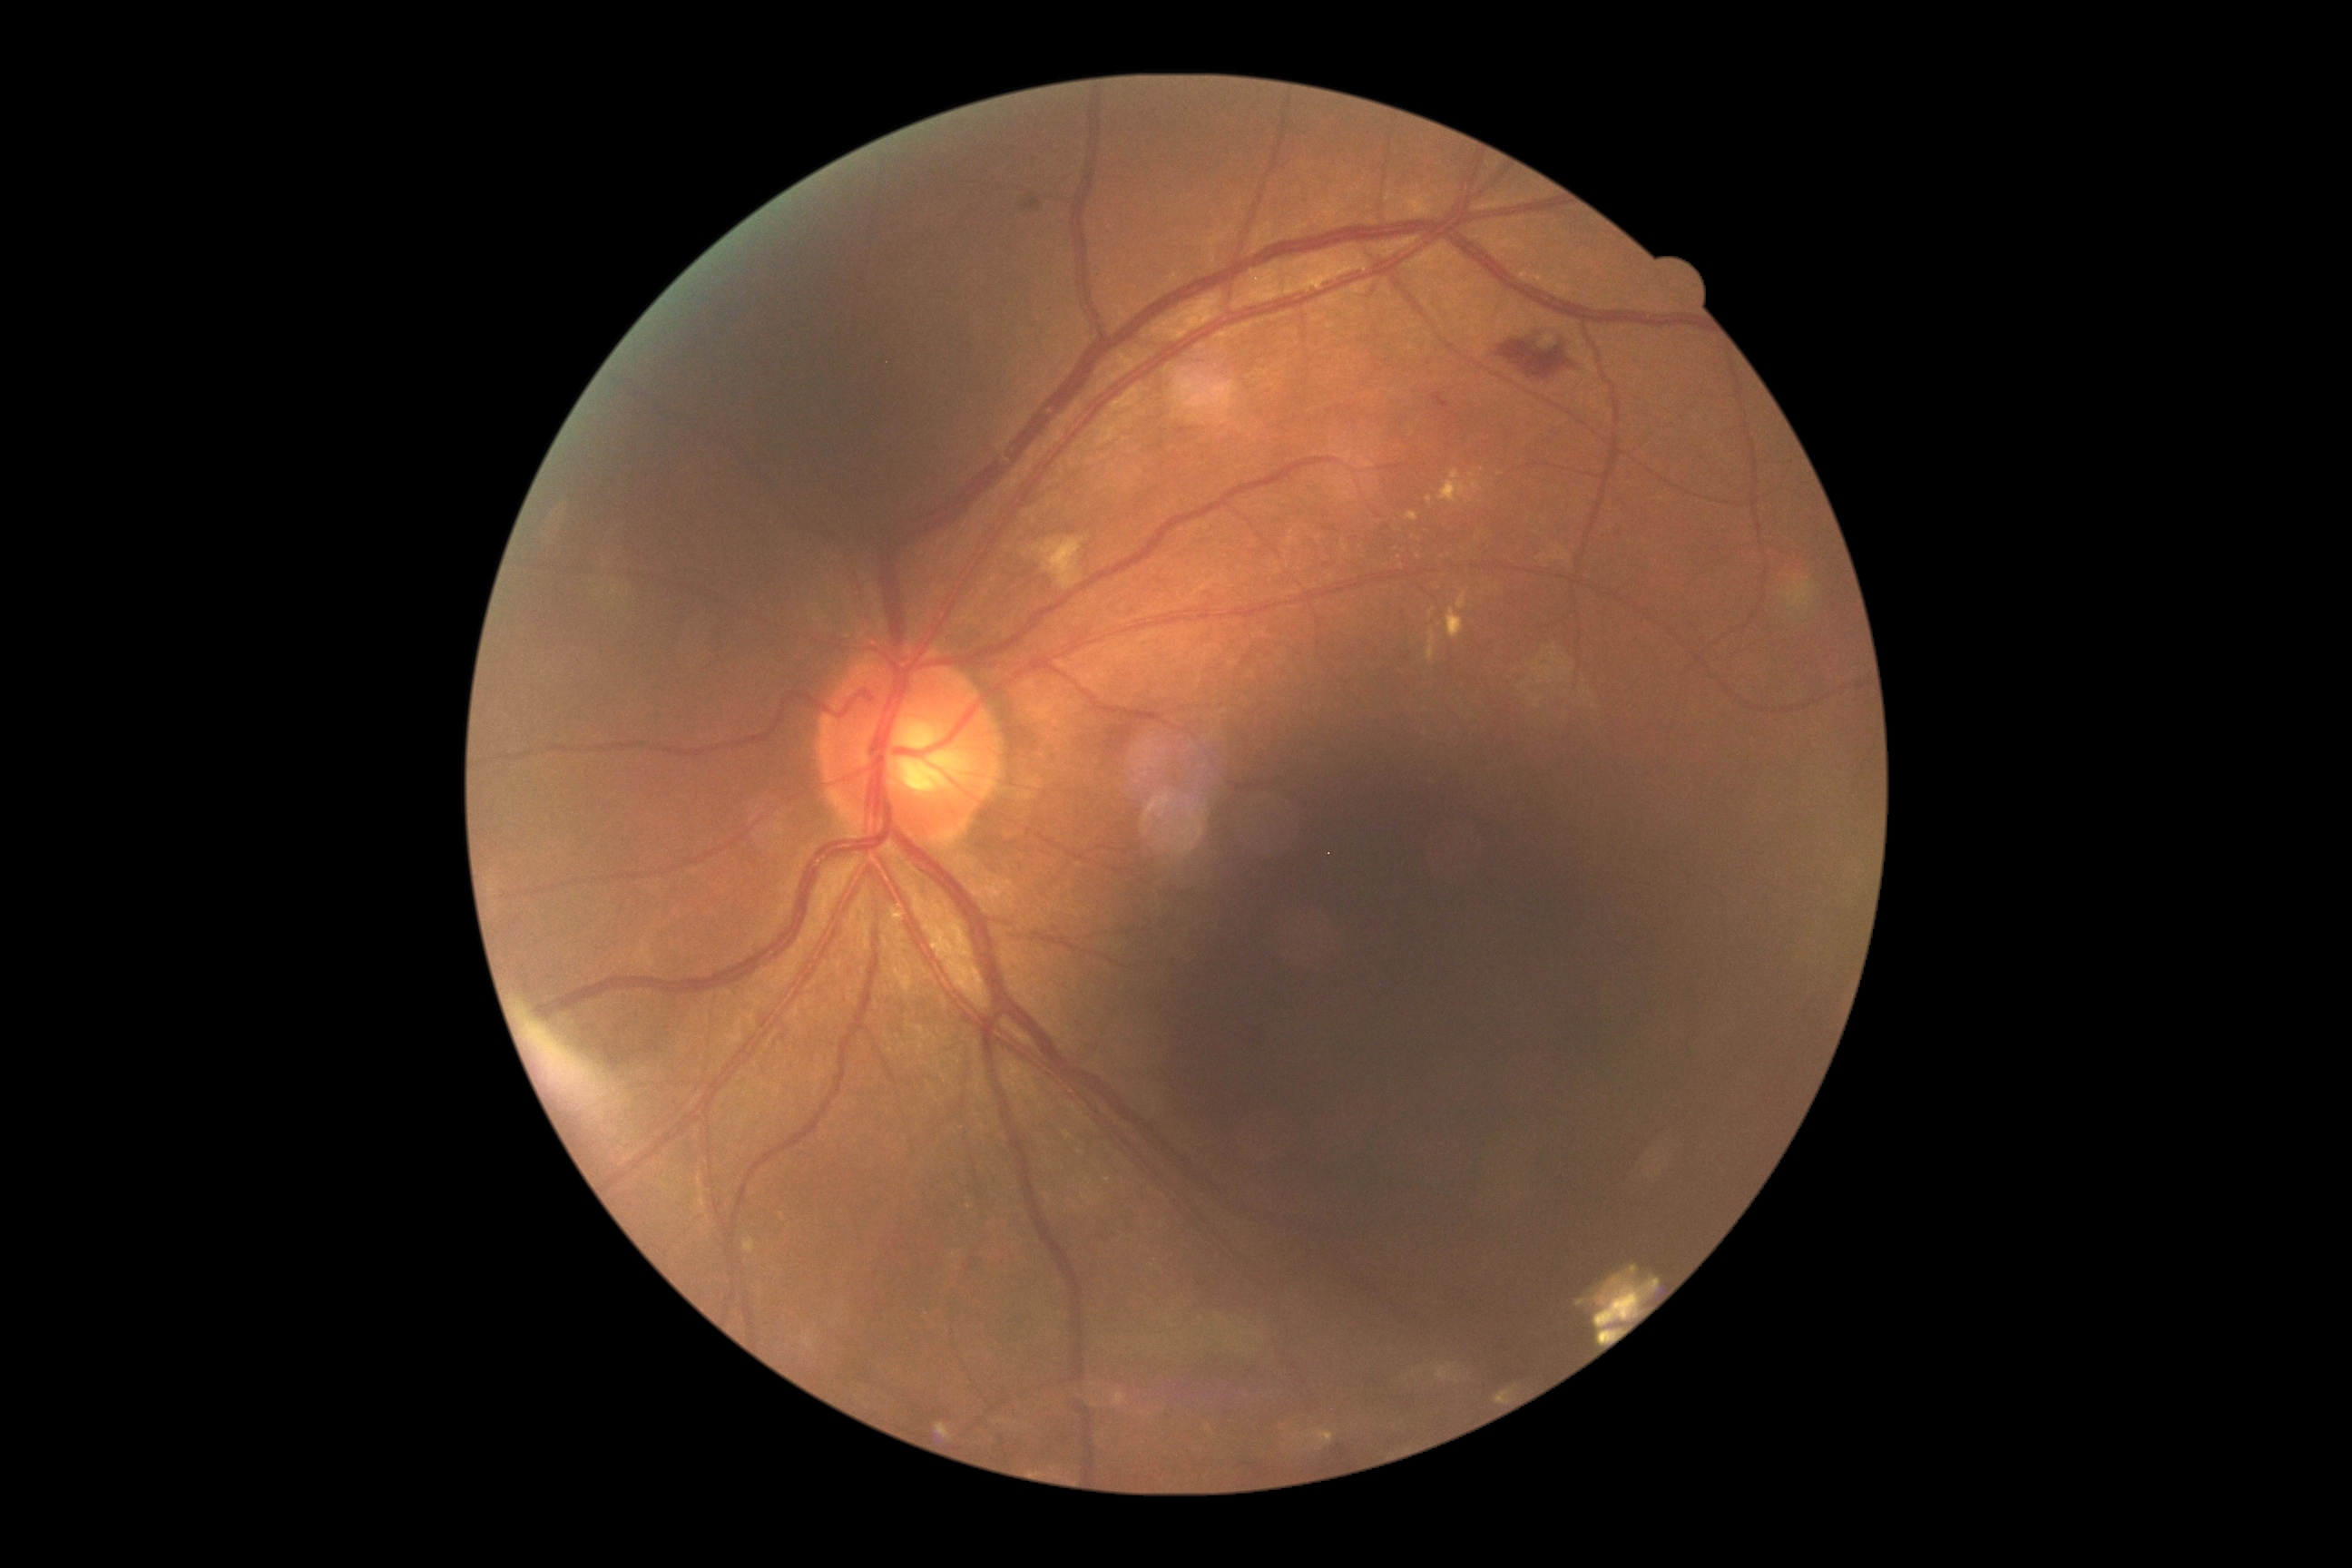 DR severity: moderate non-proliferative diabetic retinopathy (grade 2)
Representative lesions:
MAs = none
HEs = <bbox>1177, 429, 1191, 436</bbox>, <bbox>1496, 340, 1573, 380</bbox>, <bbox>1433, 393, 1451, 409</bbox>
Additional small HEs near x=1160 y=445
SEs = <bbox>1032, 536, 1084, 591</bbox>
EXs (subset) = <bbox>1446, 609, 1464, 640</bbox>, <bbox>1427, 496, 1433, 505</bbox>, <bbox>1429, 609, 1436, 620</bbox>, <bbox>1438, 471, 1482, 504</bbox>, <bbox>1427, 627, 1436, 662</bbox>, <bbox>1406, 513, 1418, 522</bbox>, <bbox>1456, 593, 1467, 609</bbox>
Additional small EXs near x=1419 y=557, x=1400 y=558, x=1483 y=469, x=1472 y=475, x=1401 y=567